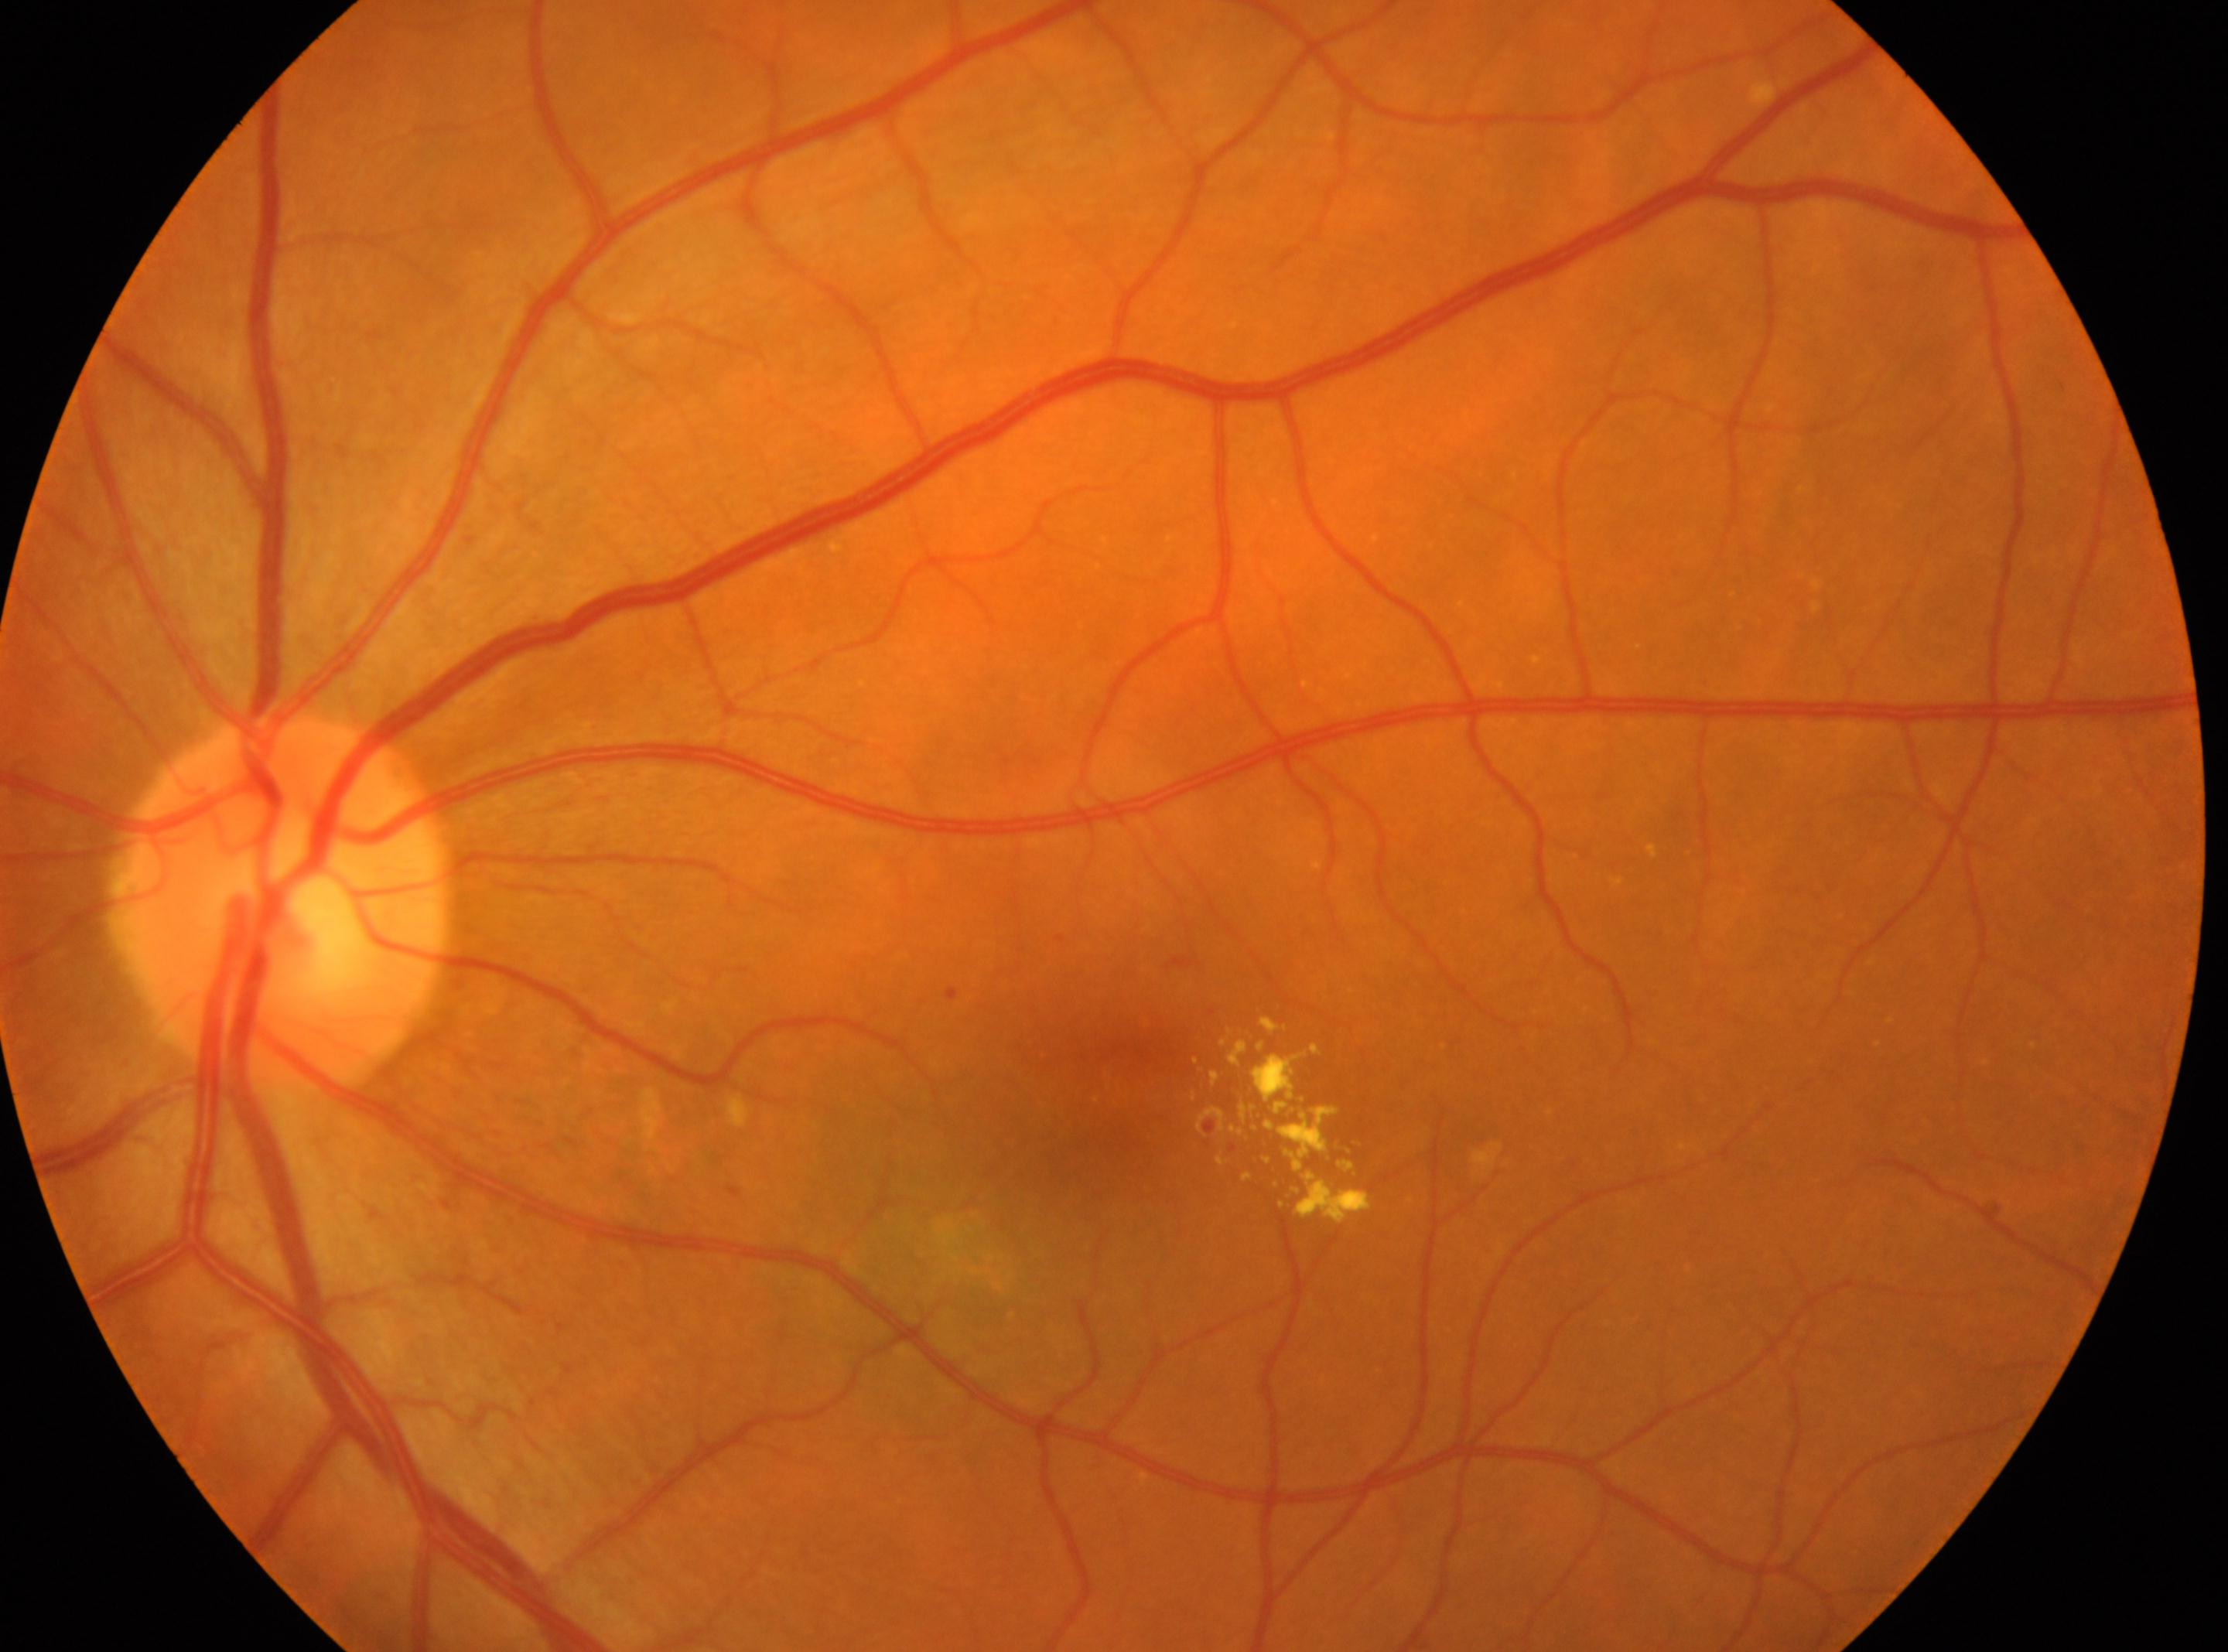

the fovea: (x: 1117, y: 1089)
the left eye
optic nerve head: (x: 280, y: 903)
retinopathy grade: 2